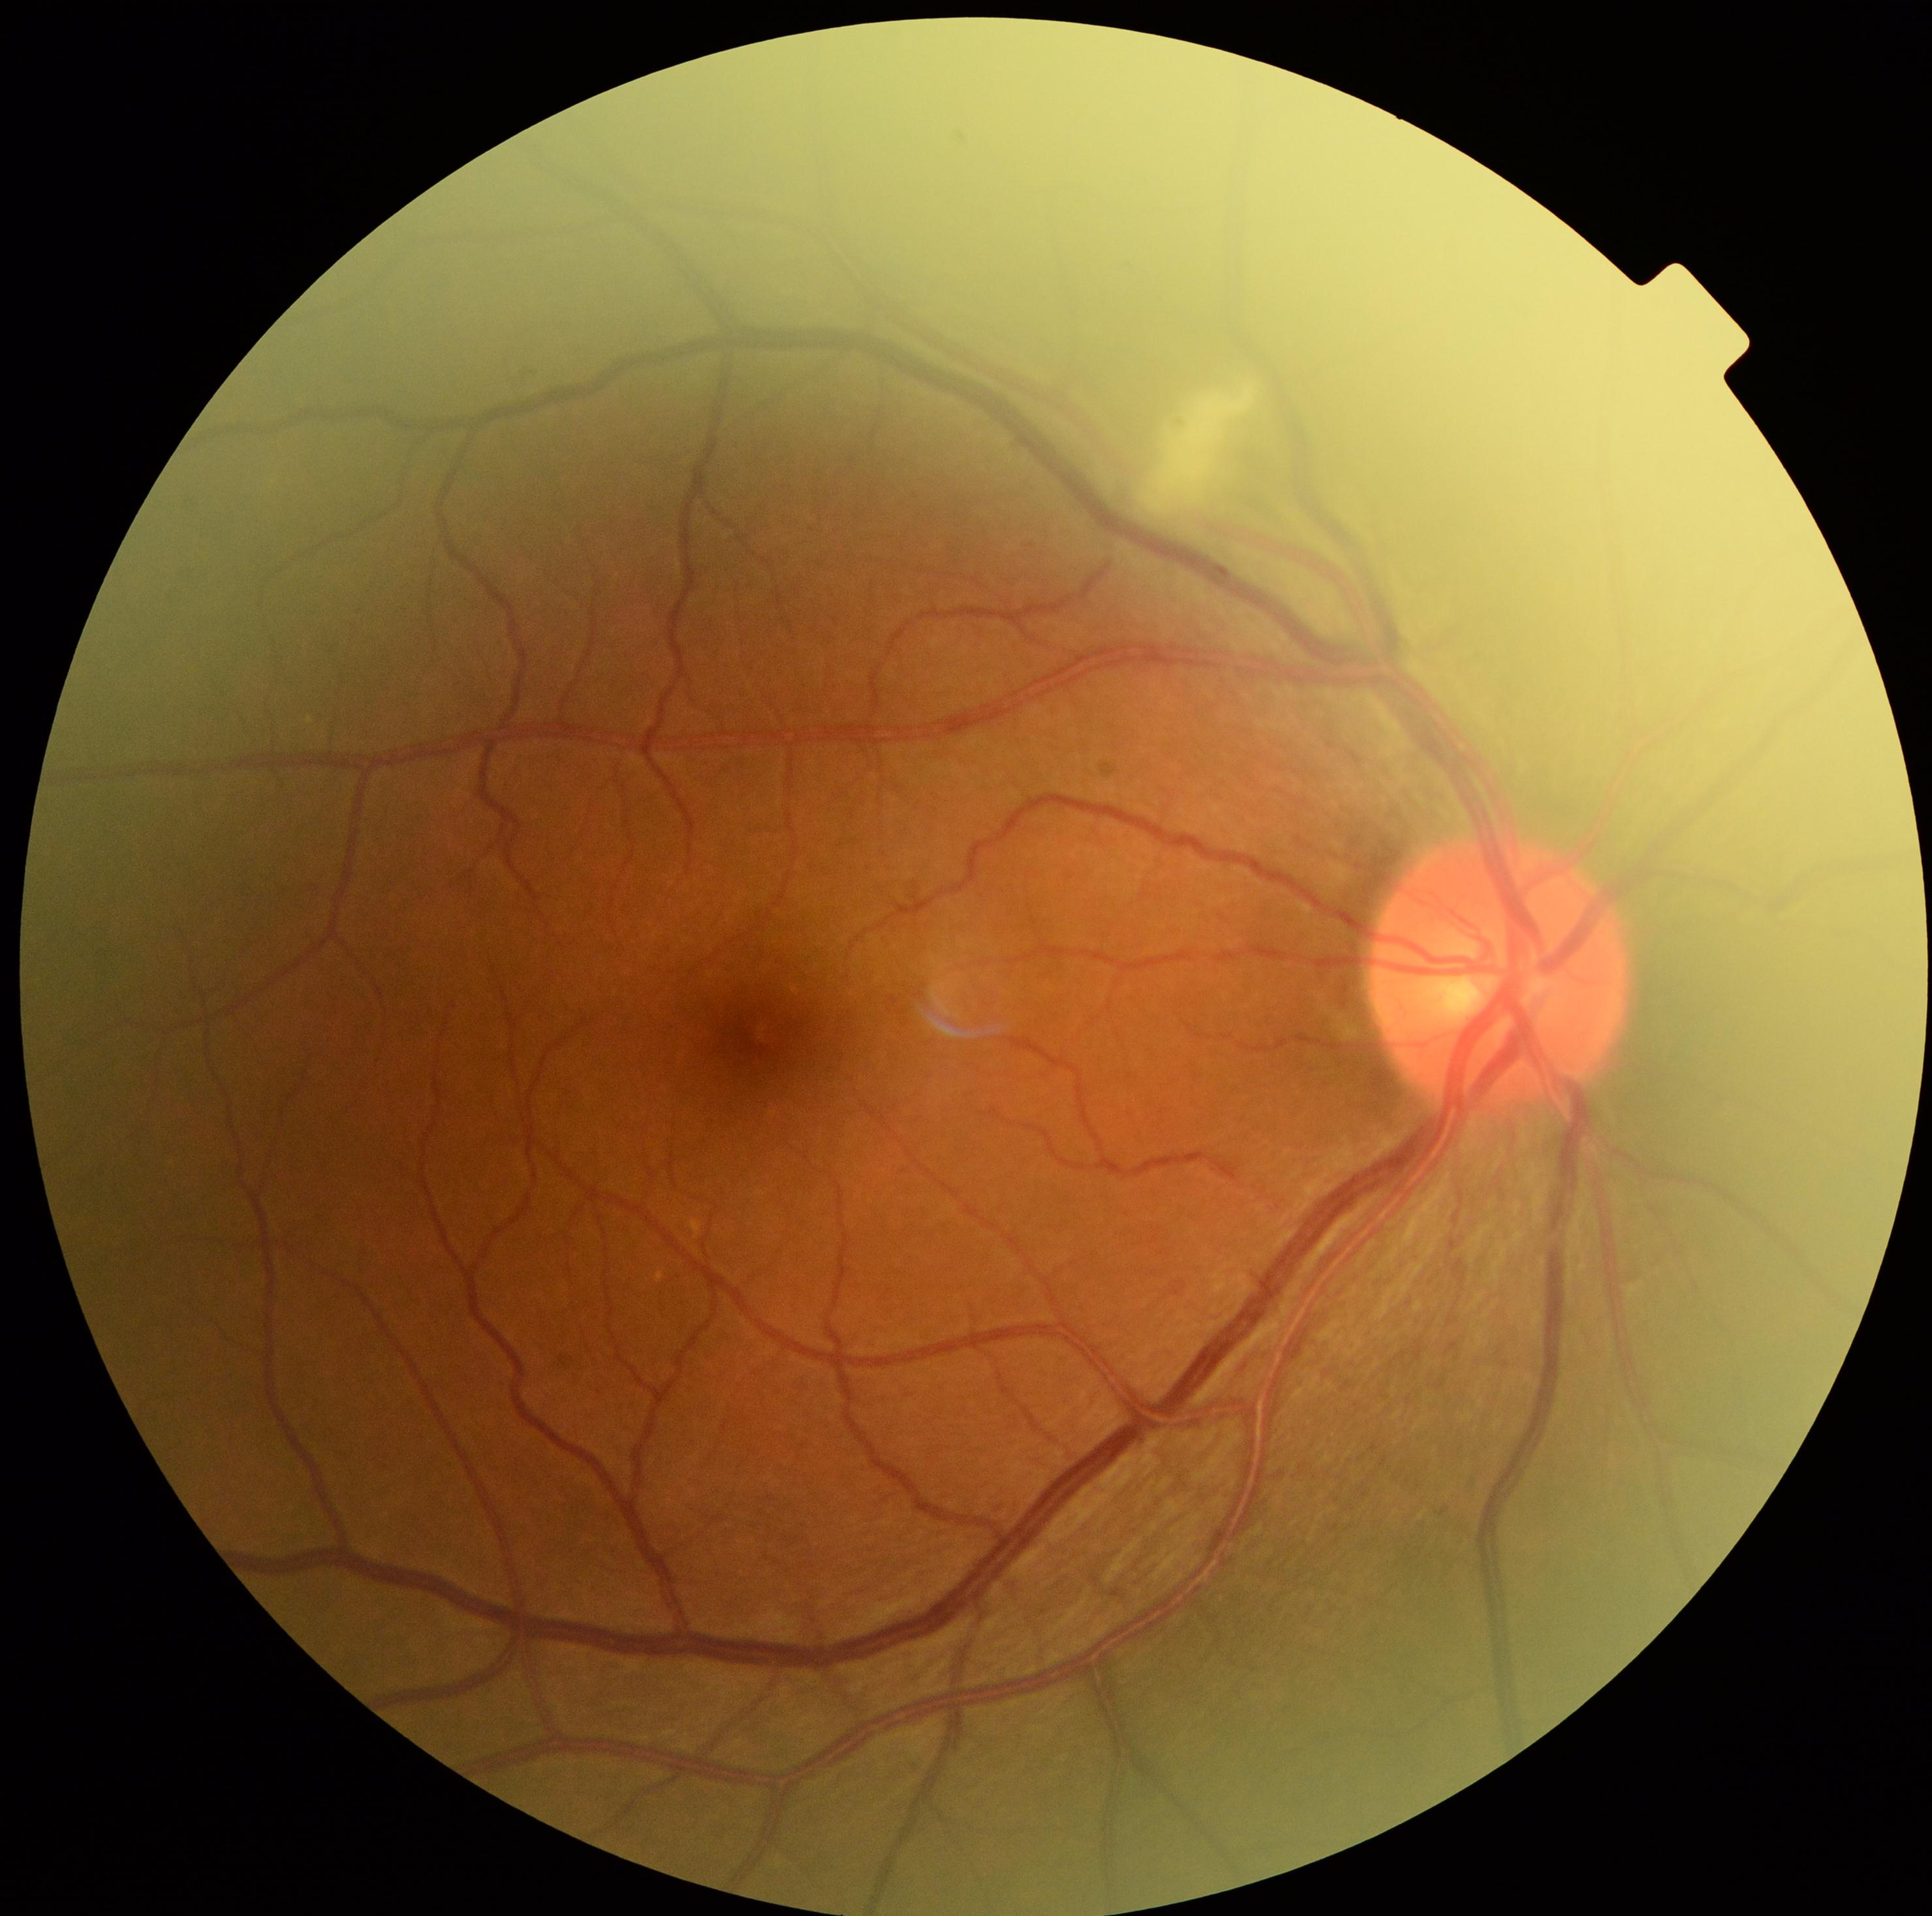 DR severity: grade 2 (moderate NPDR).